2352 by 1568 pixels; fundus photo
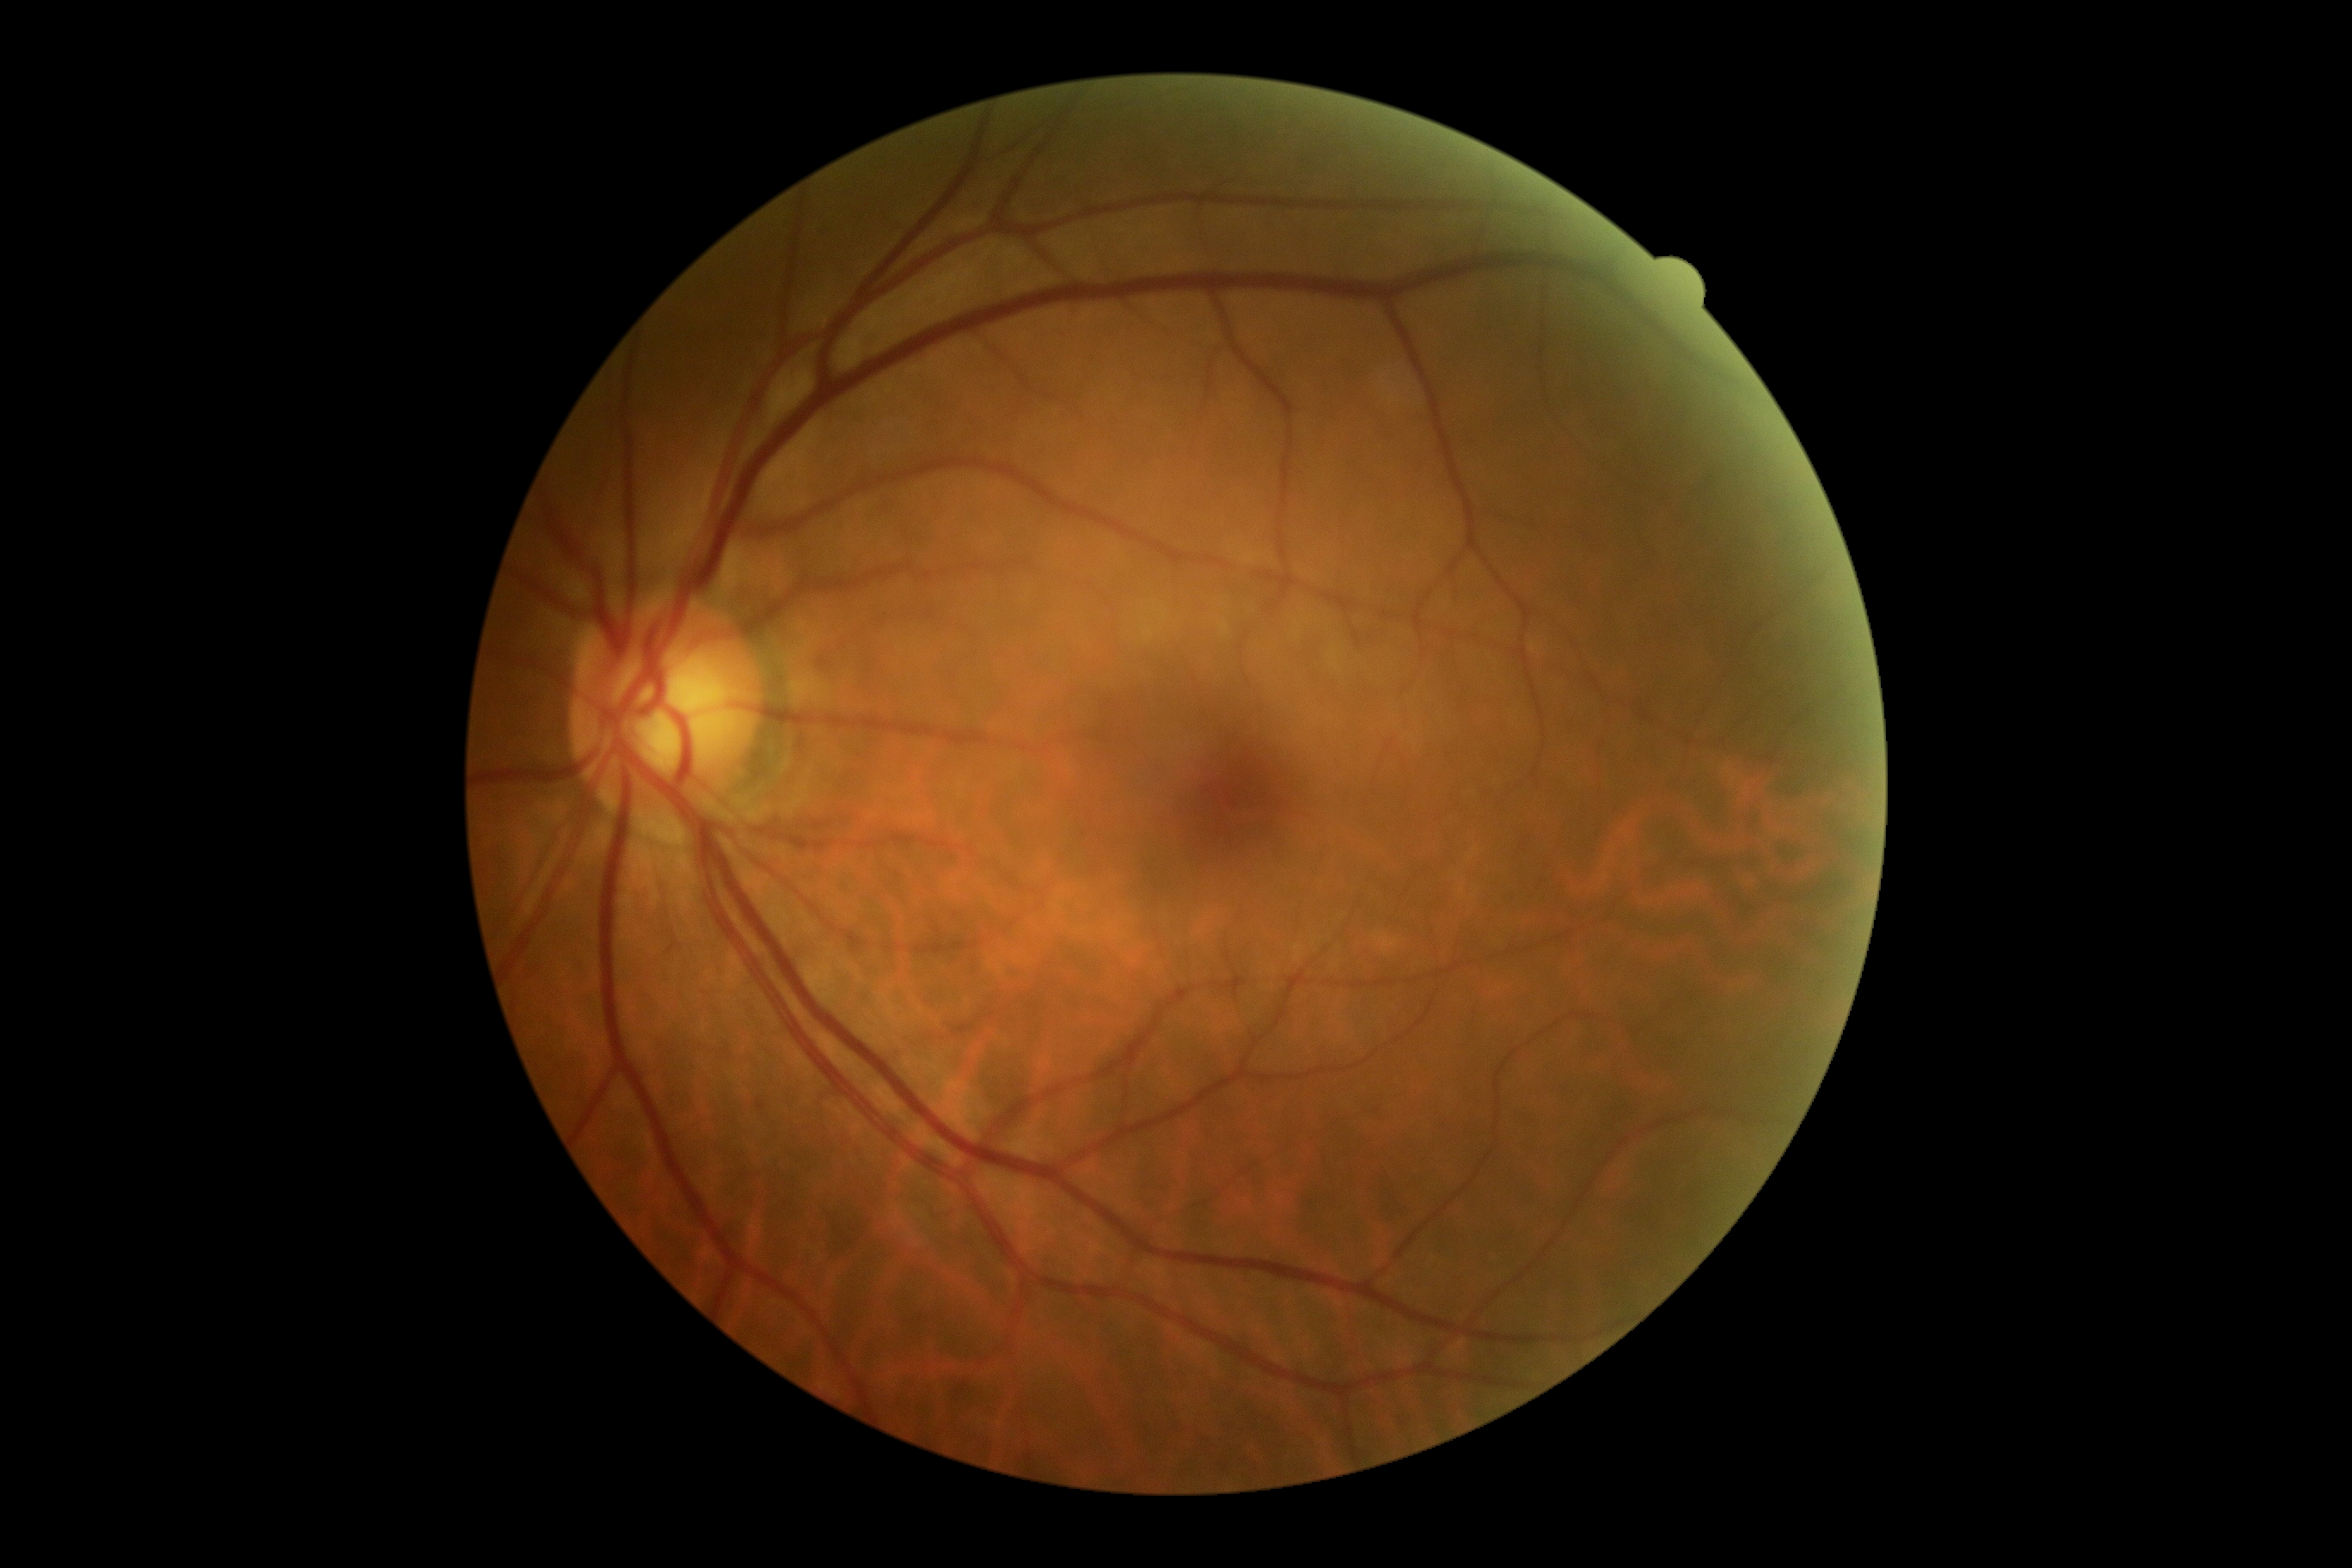
No DR findings. Diabetic retinopathy (DR): no apparent retinopathy (grade 0).